45-degree field of view — 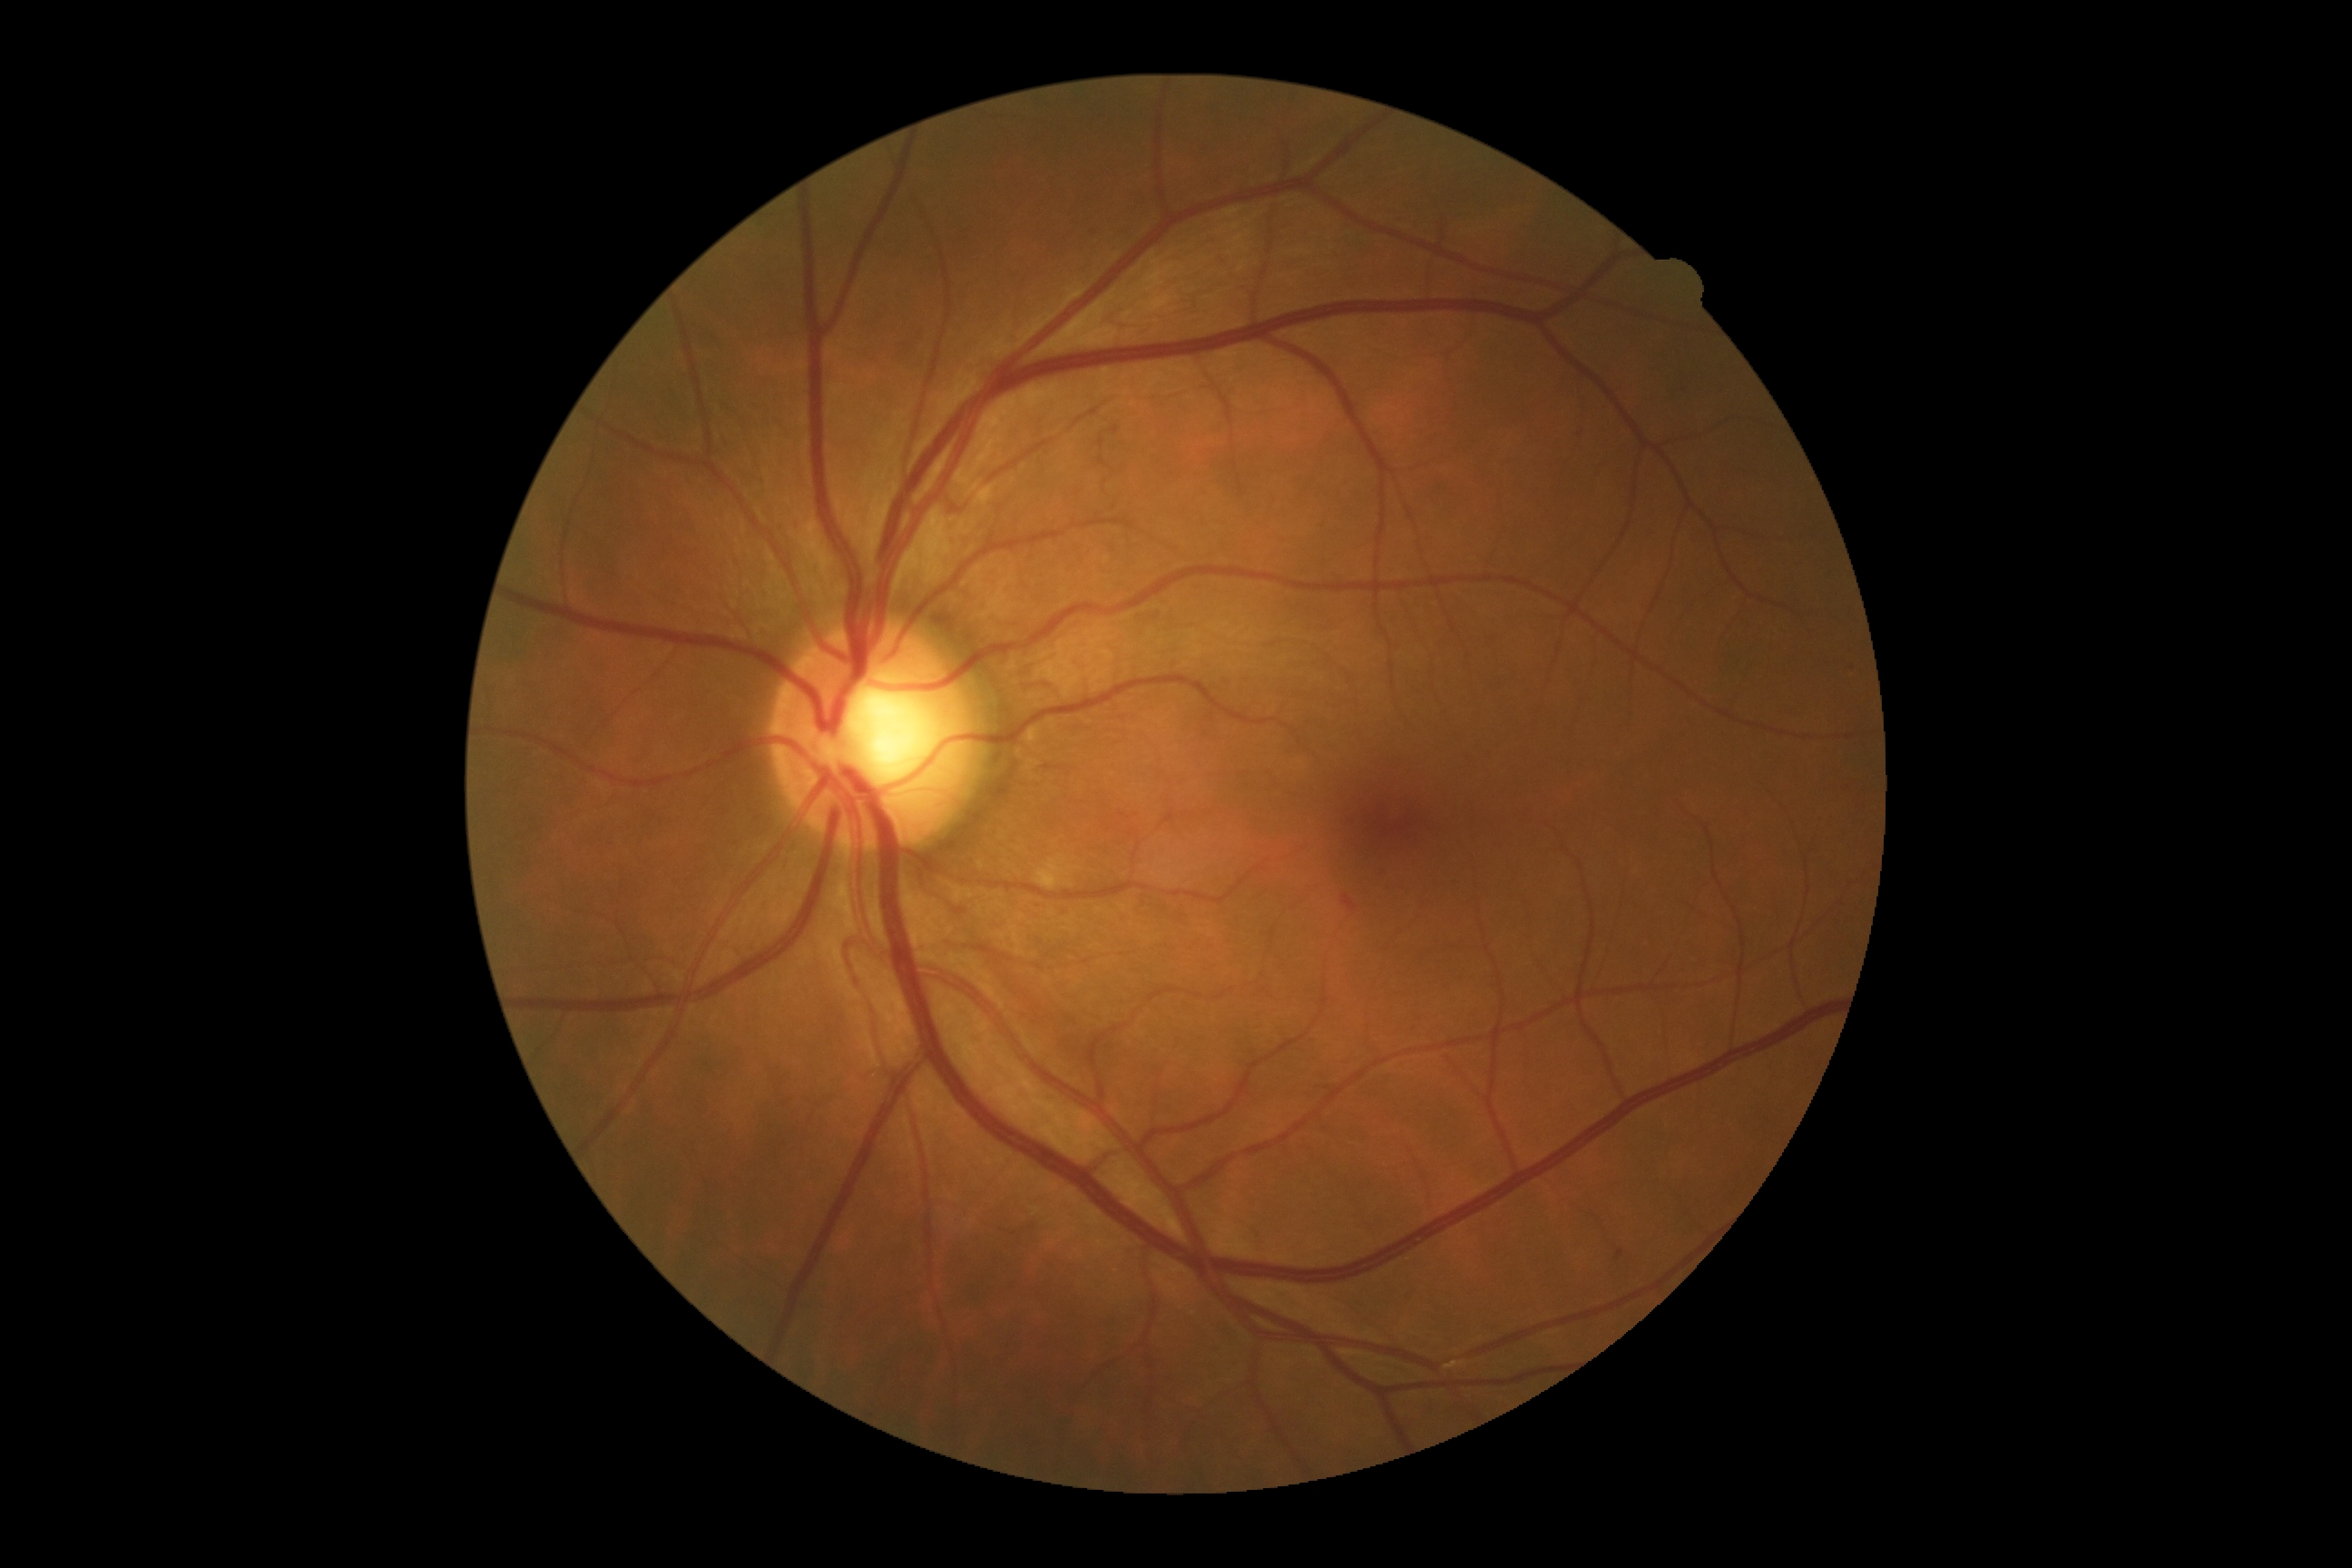 Diabetic retinopathy (DR) is grade 2 (moderate NPDR) — more than just microaneurysms but less than severe NPDR.